Axial length 24.15 mm; retinal fundus photograph; corneal thickness: 587 µm; age 53.
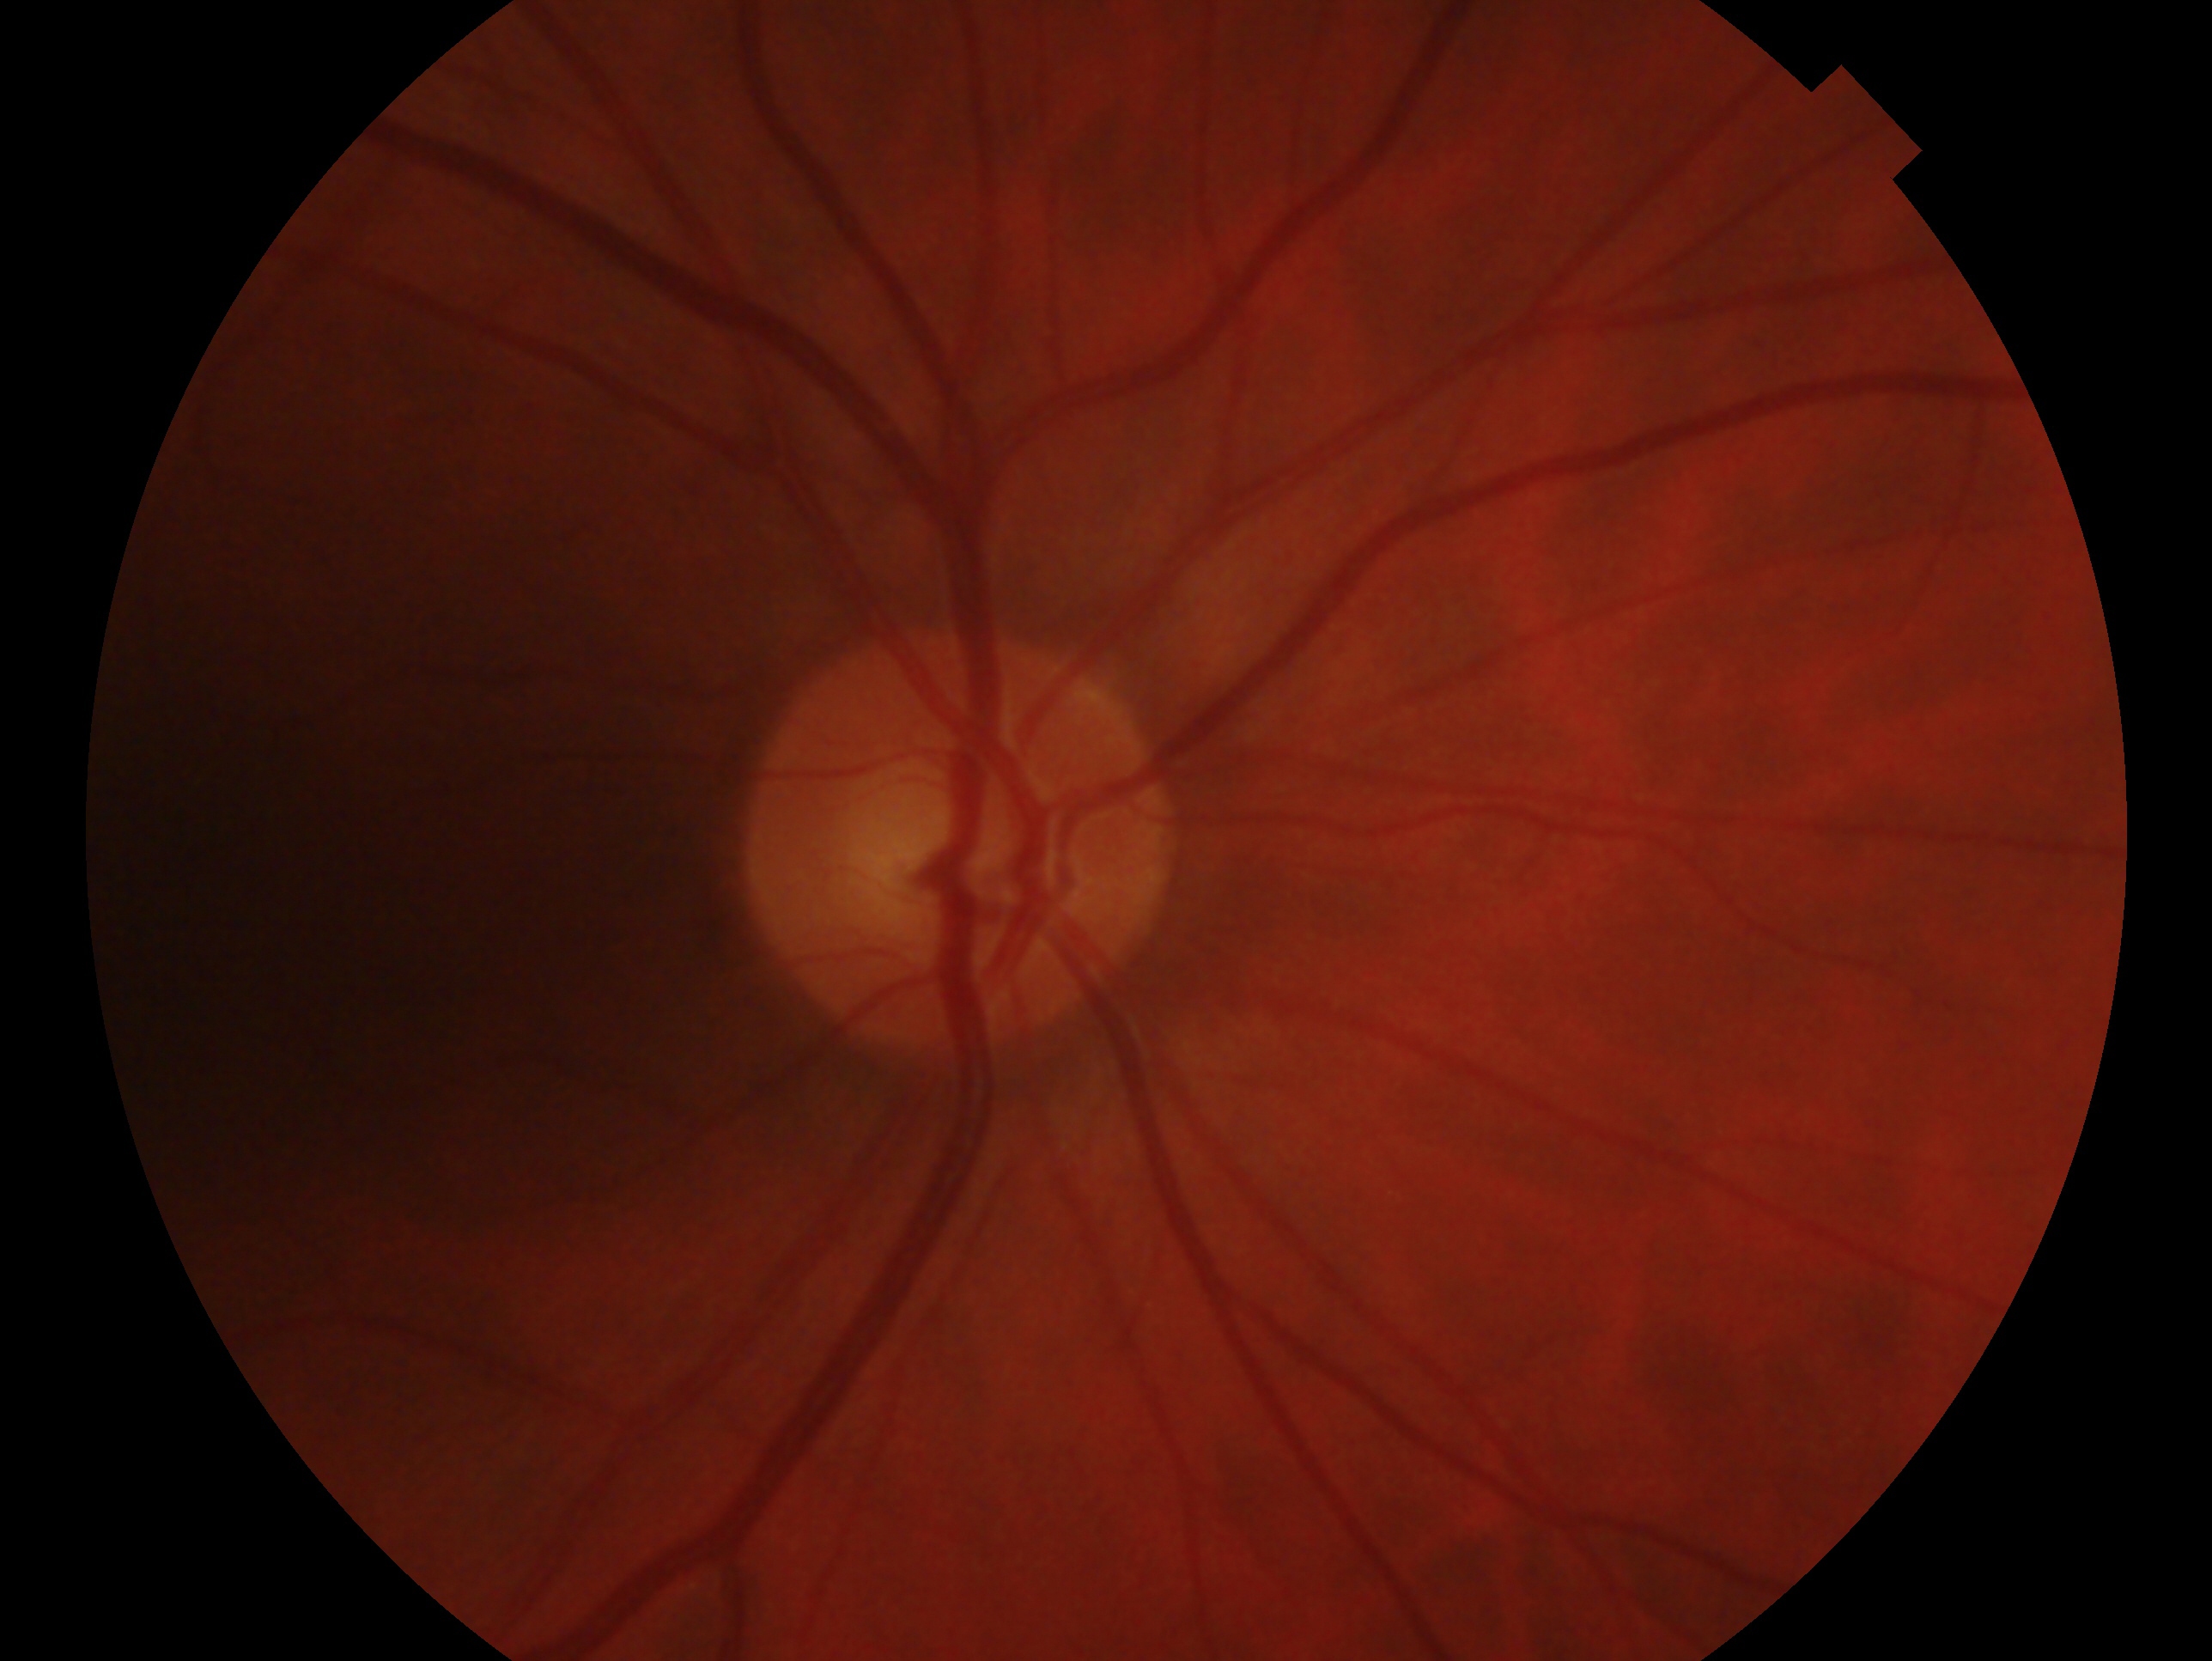
Diagnosis: no glaucoma.
Imaged eye: right eye.